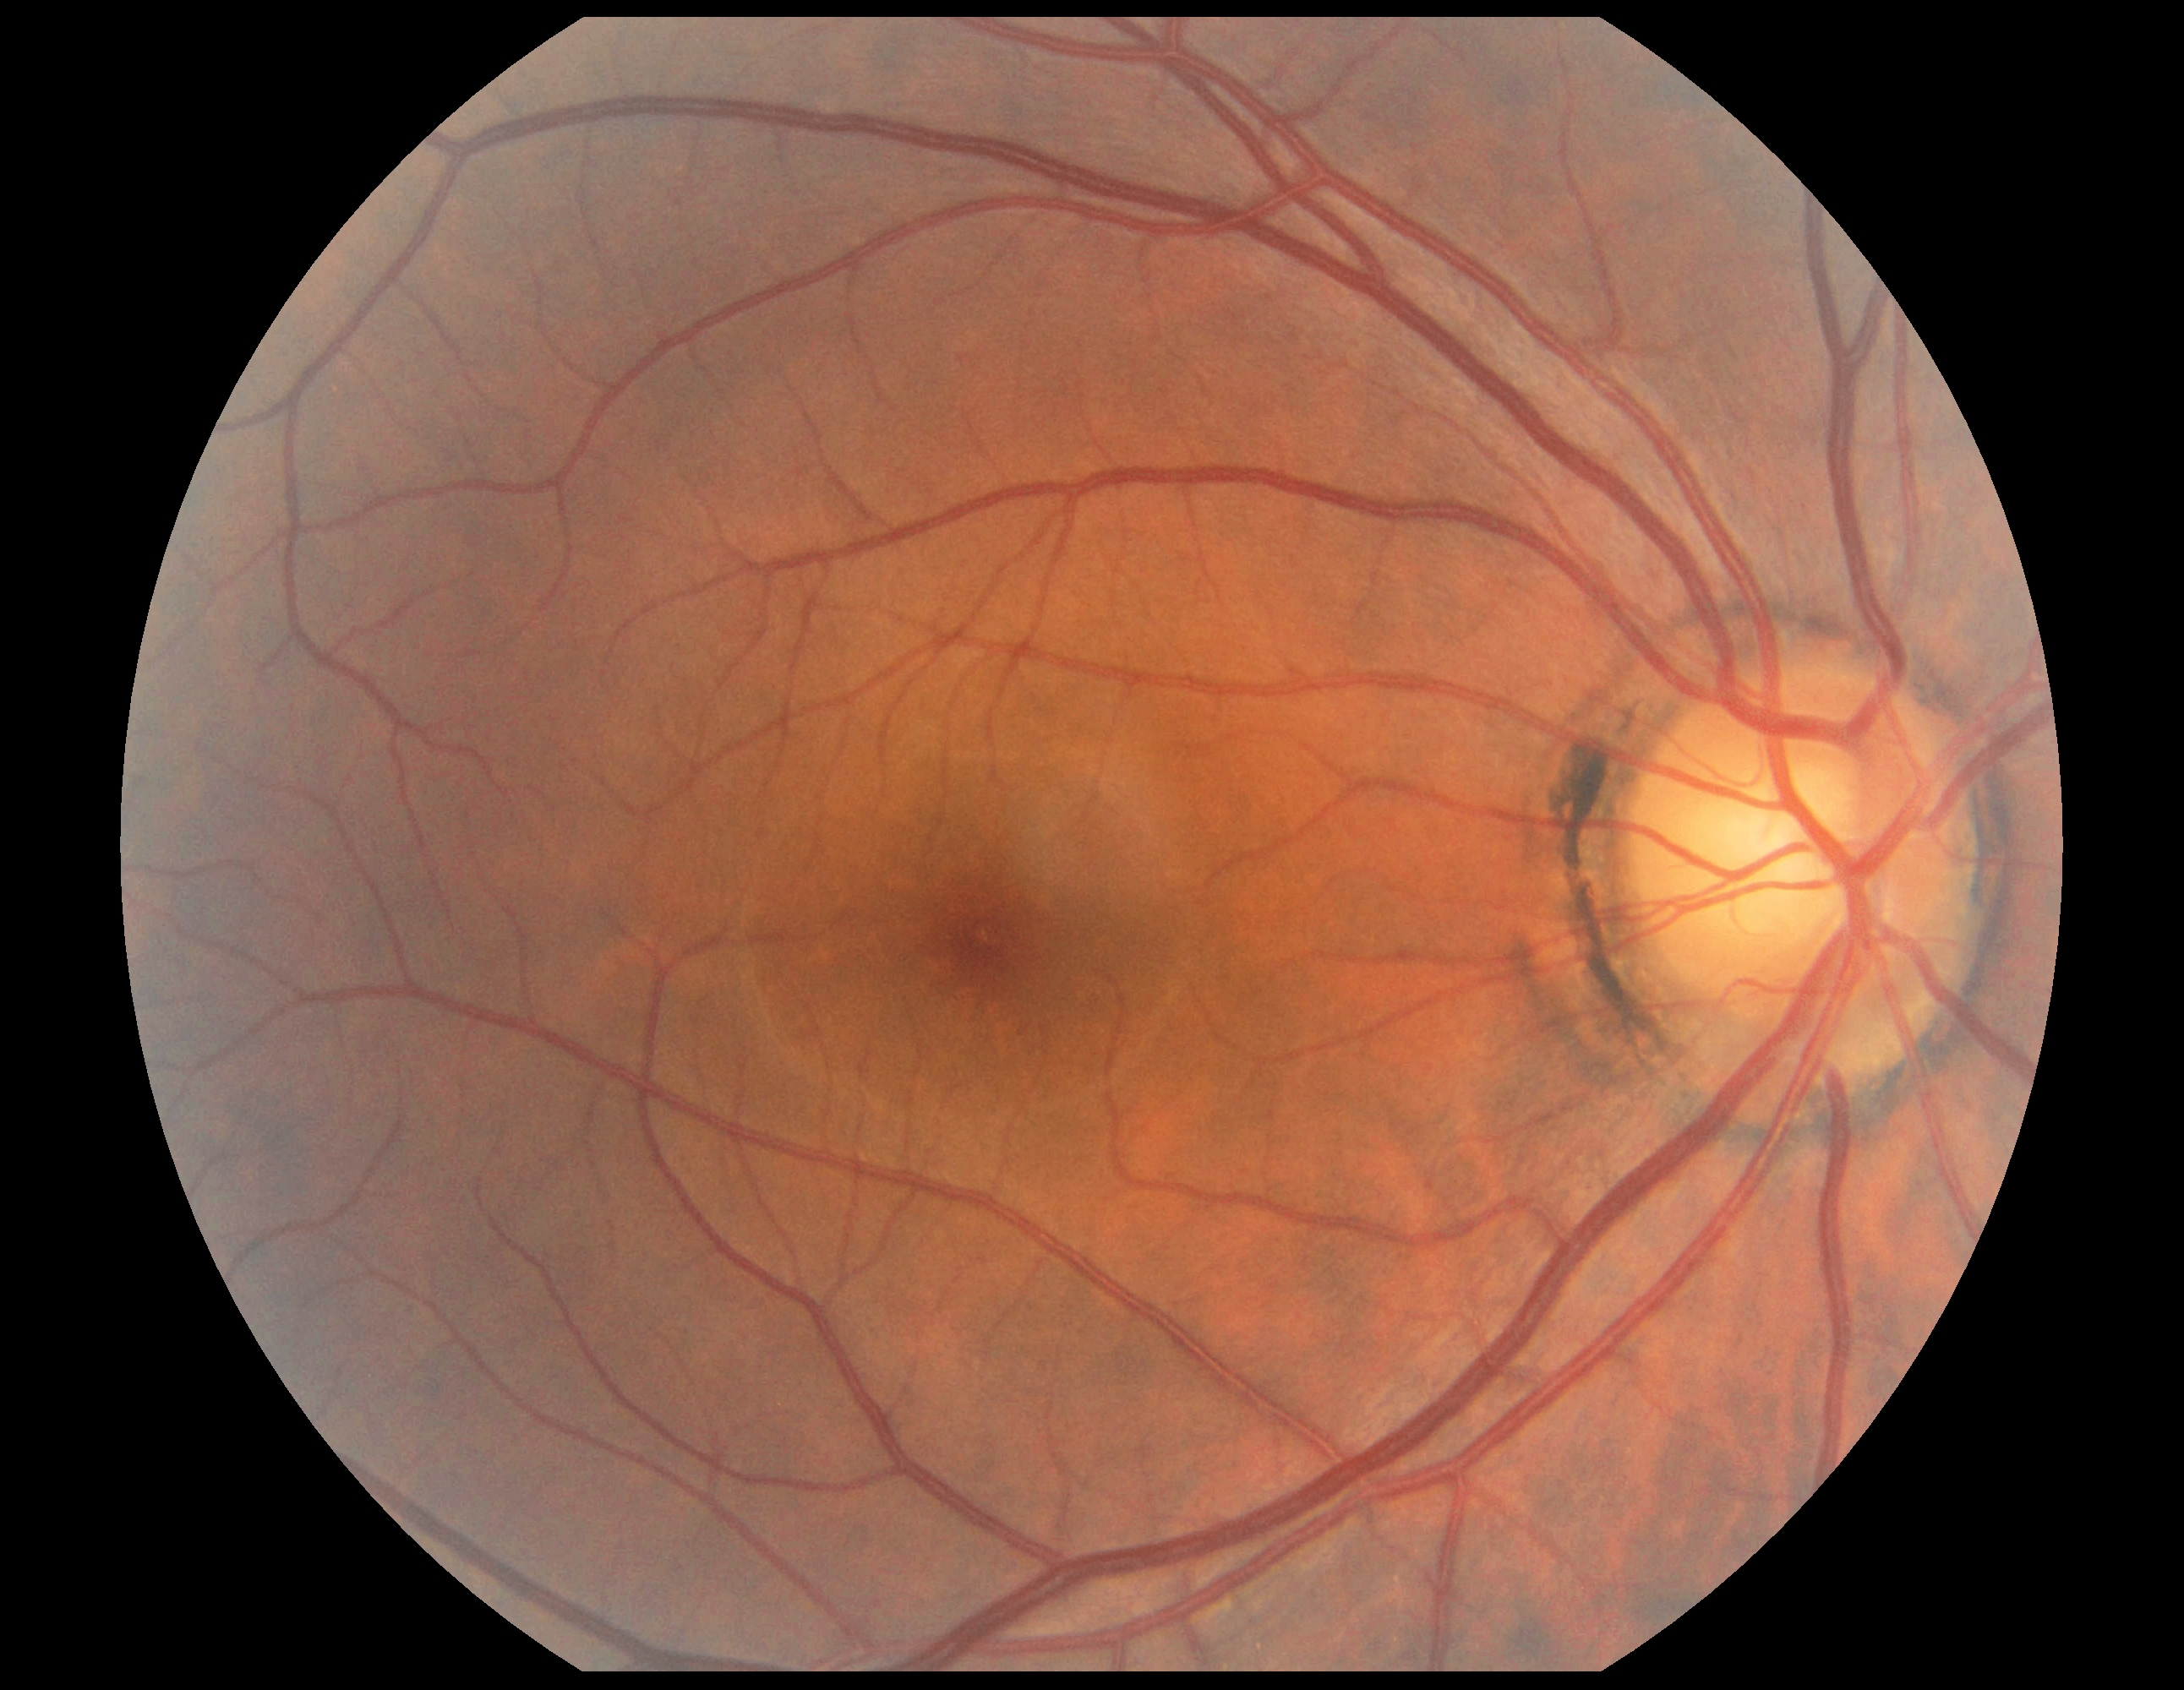

DR stage is grade 0 (no apparent retinopathy).